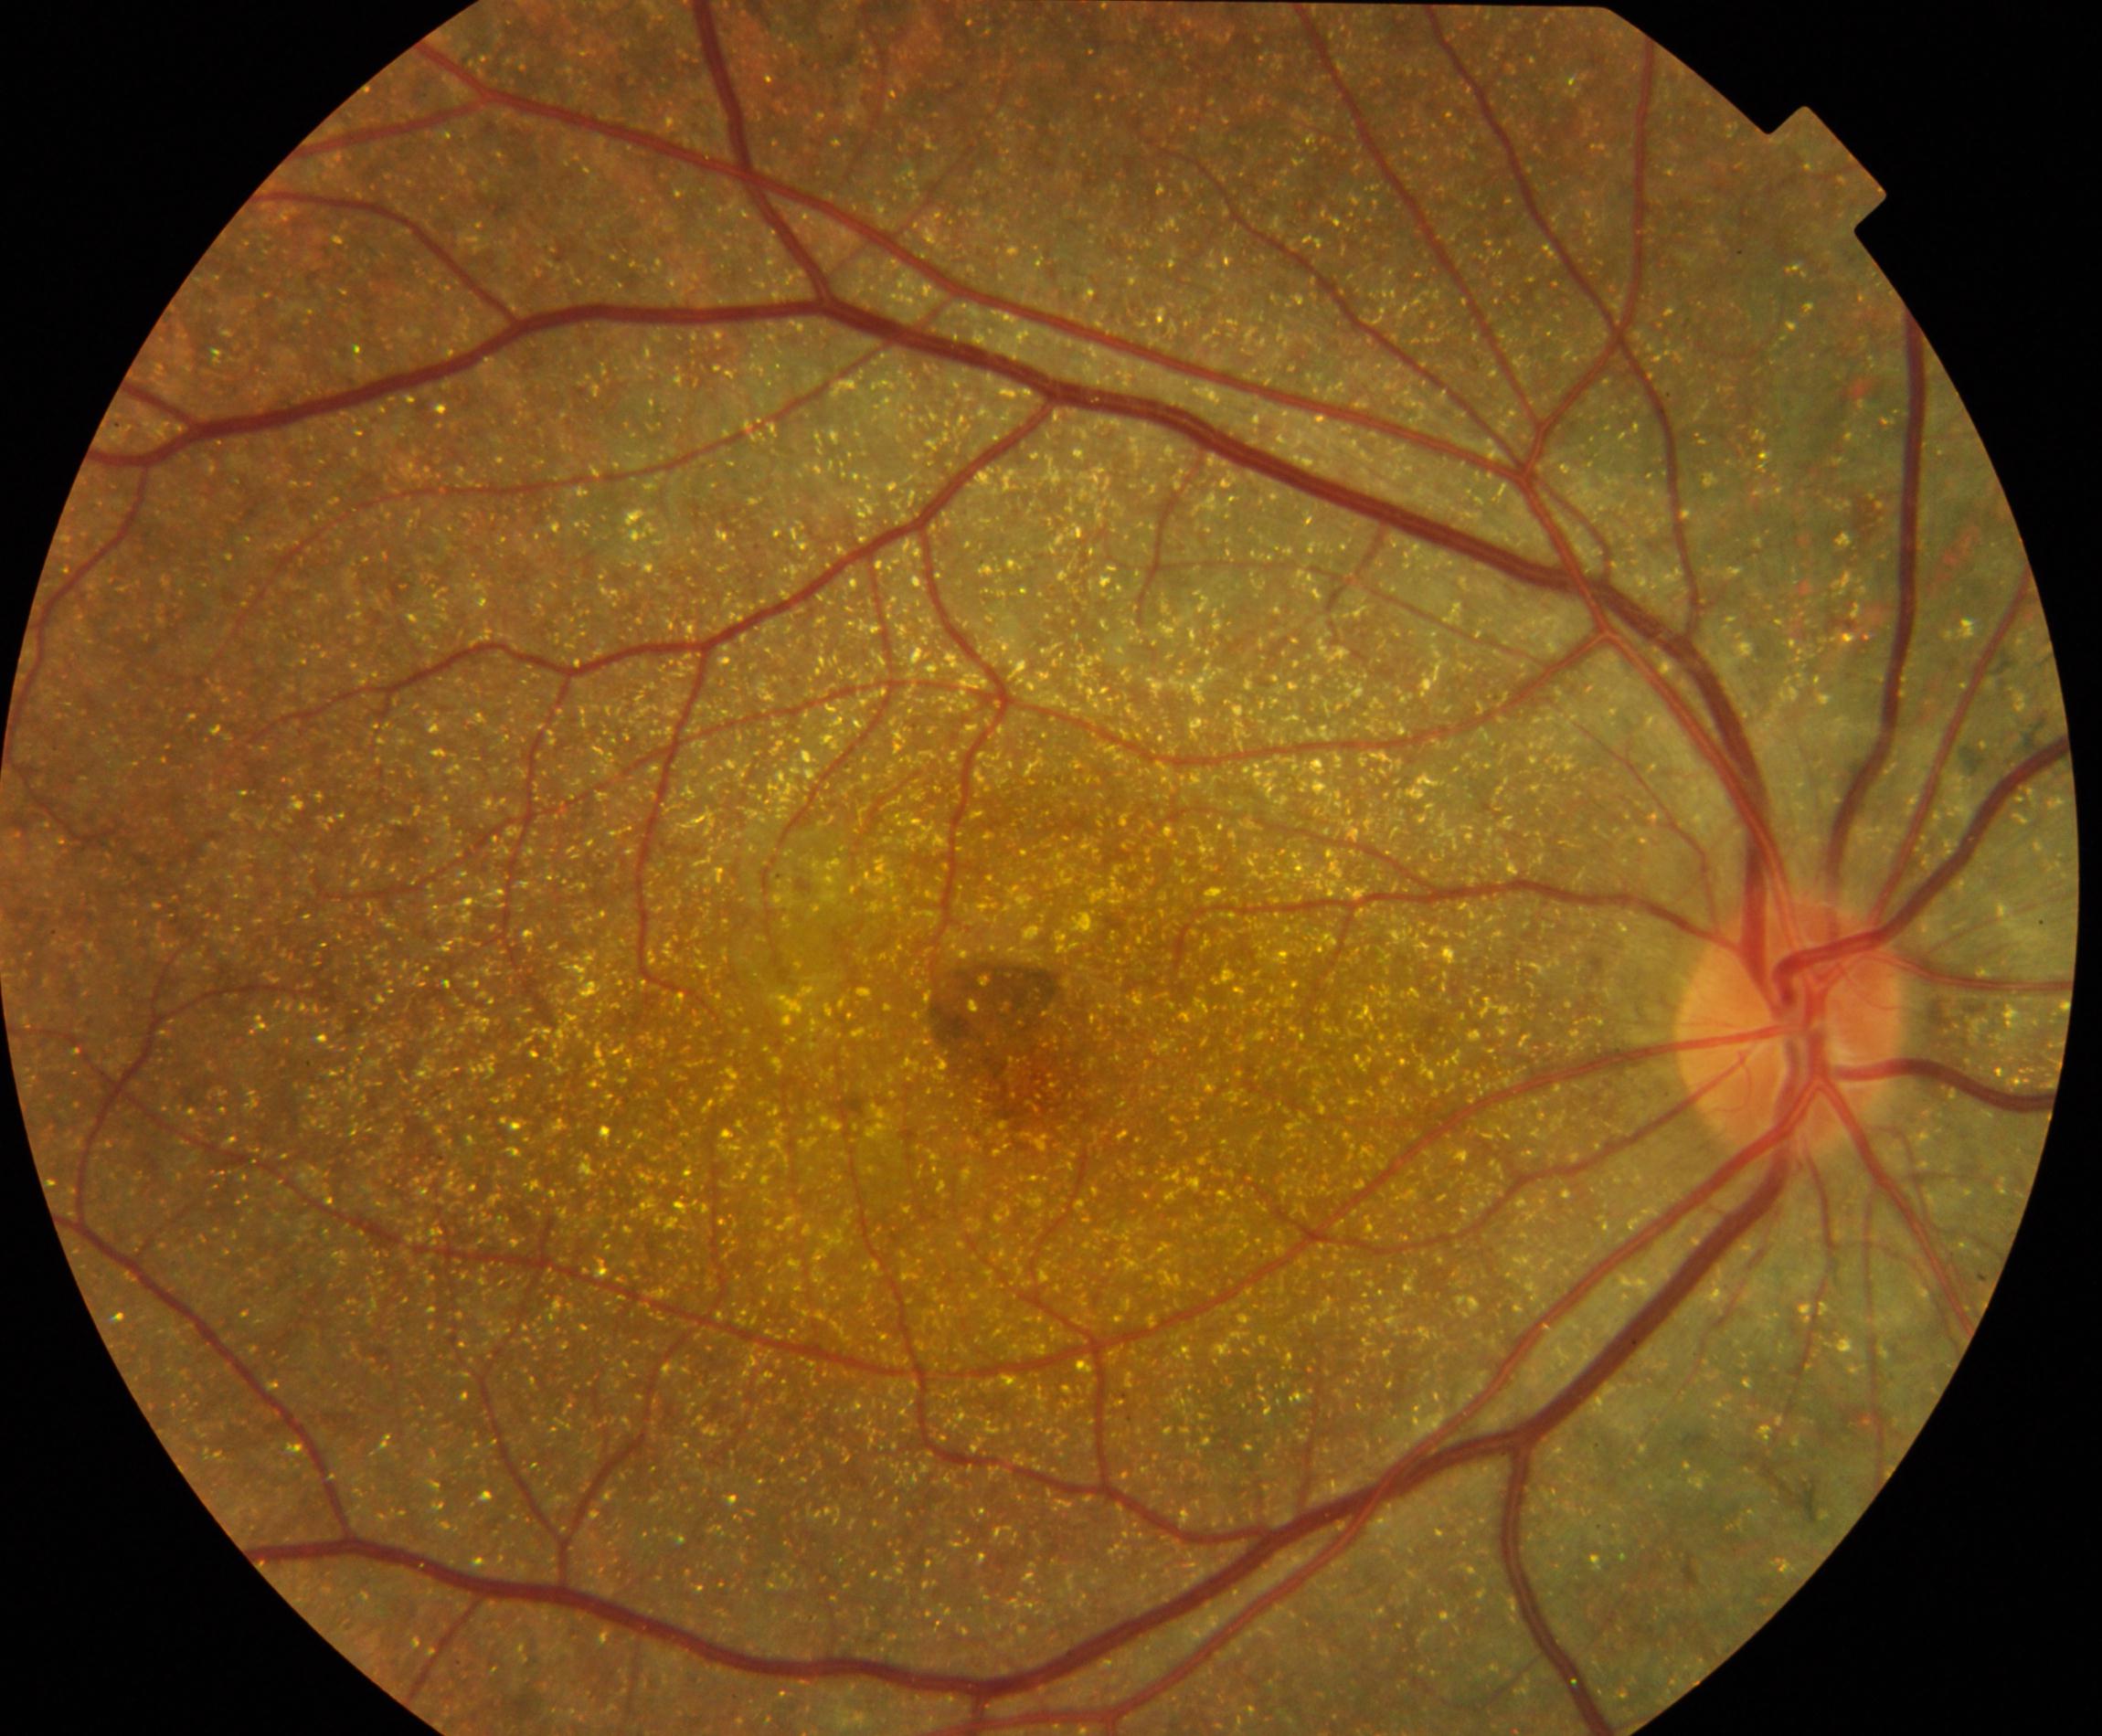 Primary finding: Bietti crystalline dystrophy.